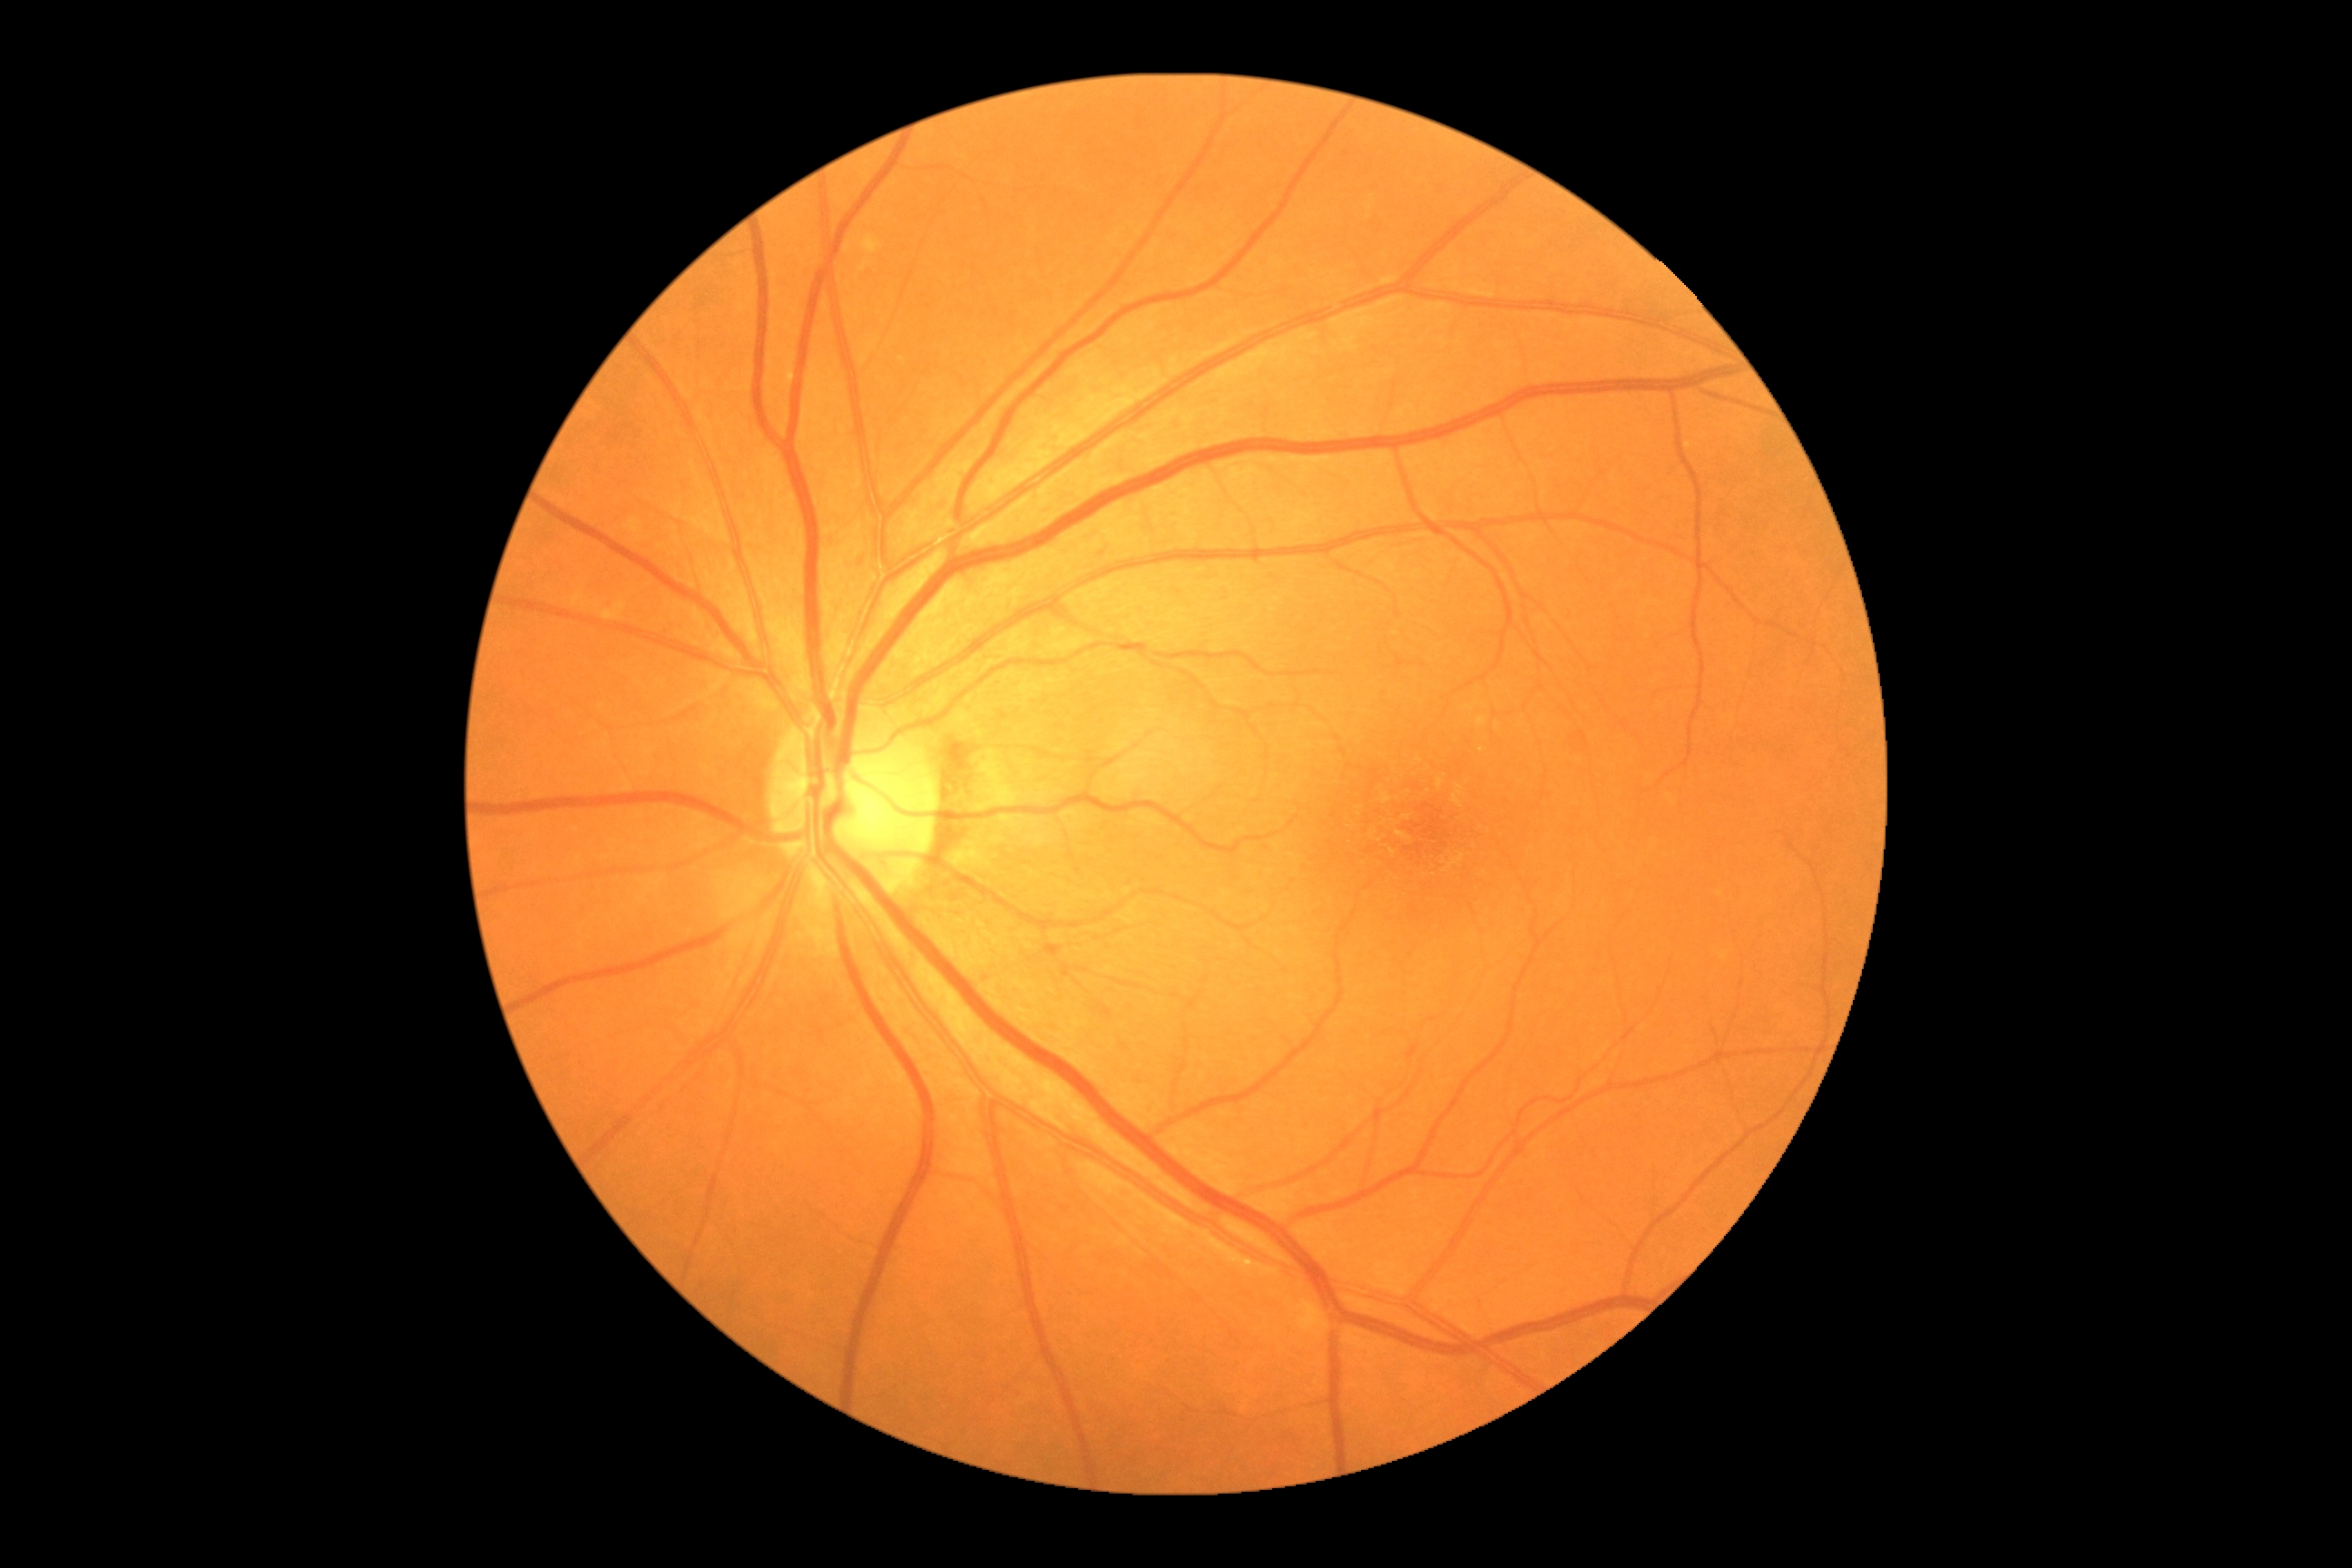
dr_grade: grade 0 (no apparent retinopathy)
dr_impression: negative for DR